Phoenix ICON wide-field infant fundus image; 100° field of view (Phoenix ICON)
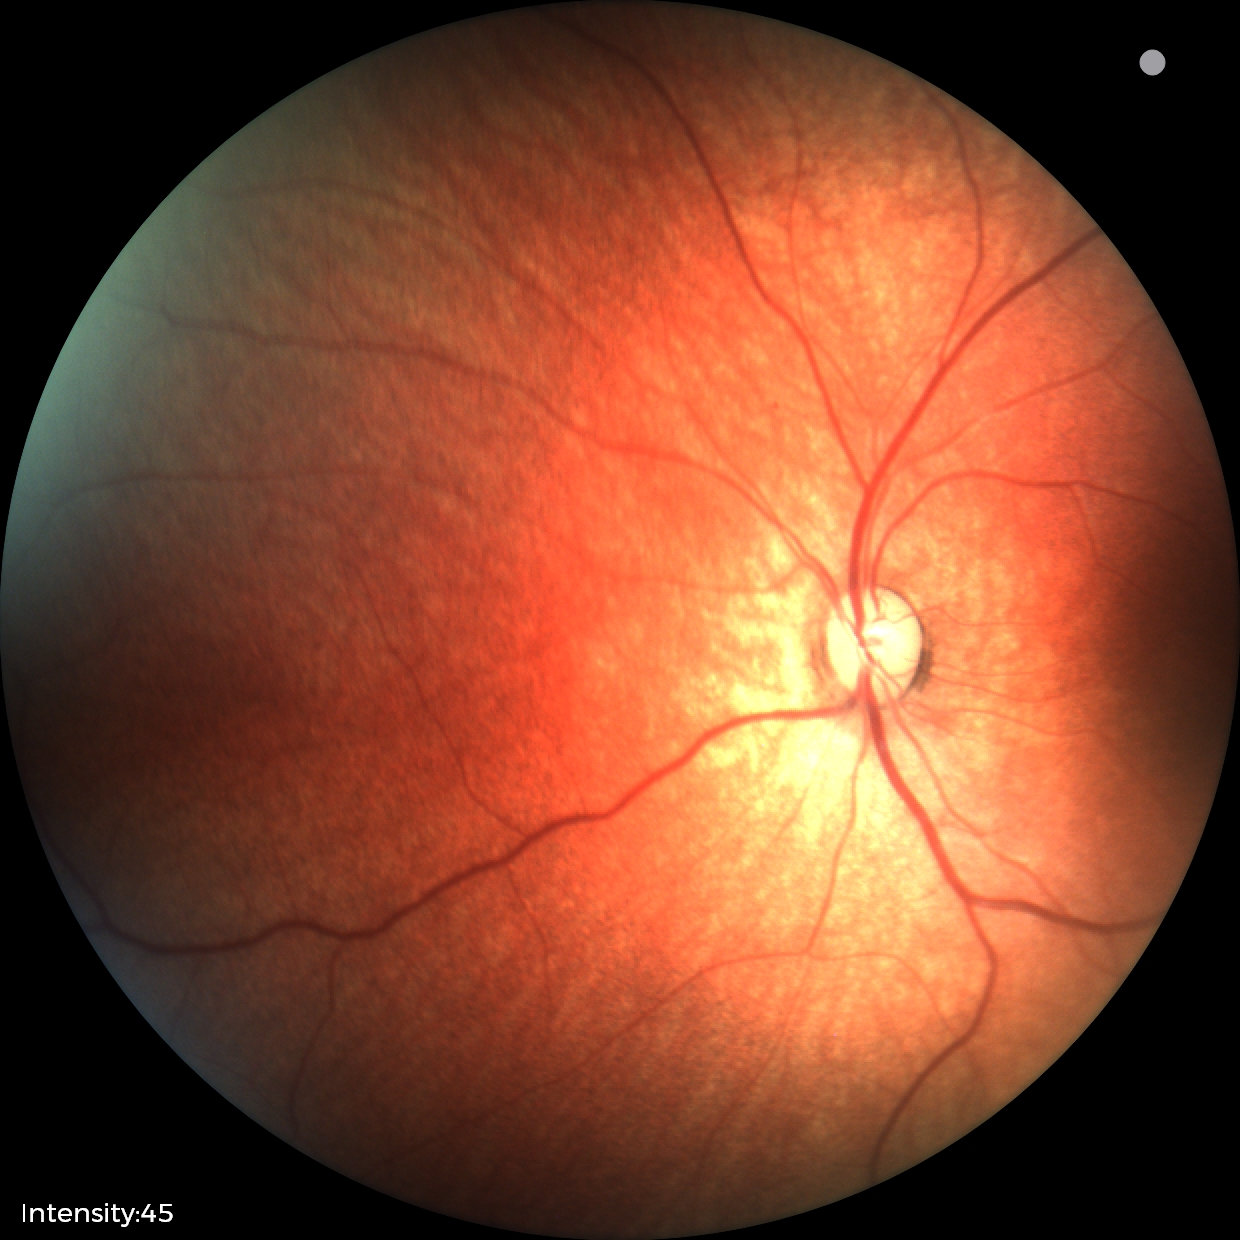
Screening examination diagnosed as physiological.